848 by 848 pixels, Davis DR grading, without pupil dilation
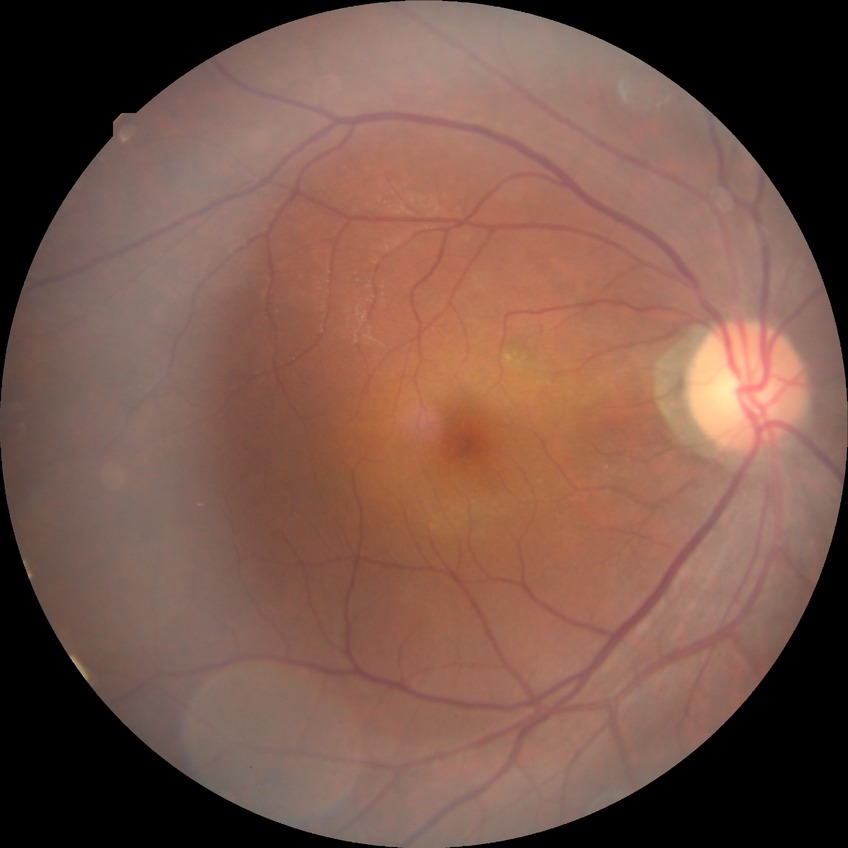
diabetic retinopathy grade: no diabetic retinopathy.